240 x 240 pixels; centered on the optic disc.
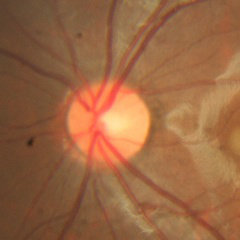

No glaucomatous findings.